RetCam wide-field infant fundus image:
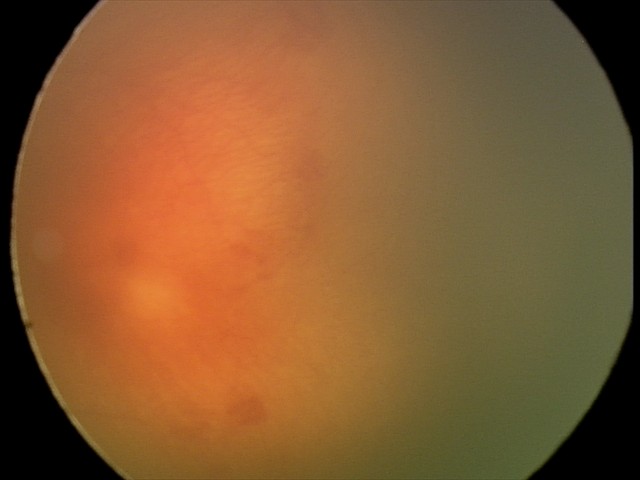

With plus disease. Screening series with aggressive ROP (A-ROP).